Modified Davis grading · posterior pole photograph · 45° FOV · no pharmacologic dilation: 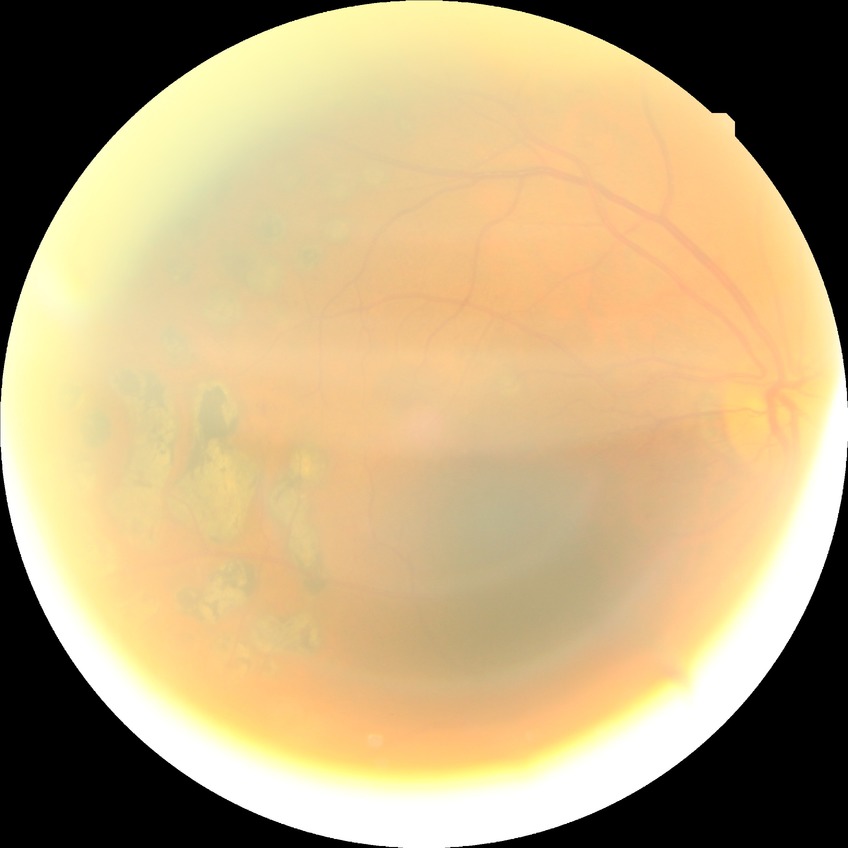 Diabetic retinopathy (DR): proliferative diabetic retinopathy (PDR).